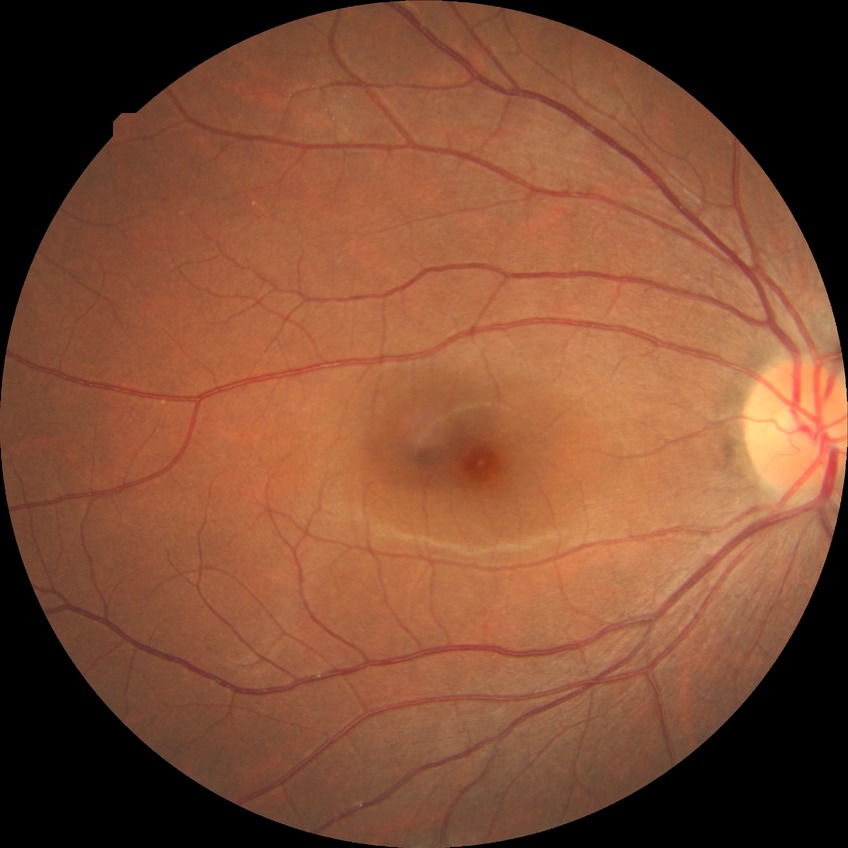
diabetic retinopathy (DR) = NDR (no diabetic retinopathy).